50-degree field of view: 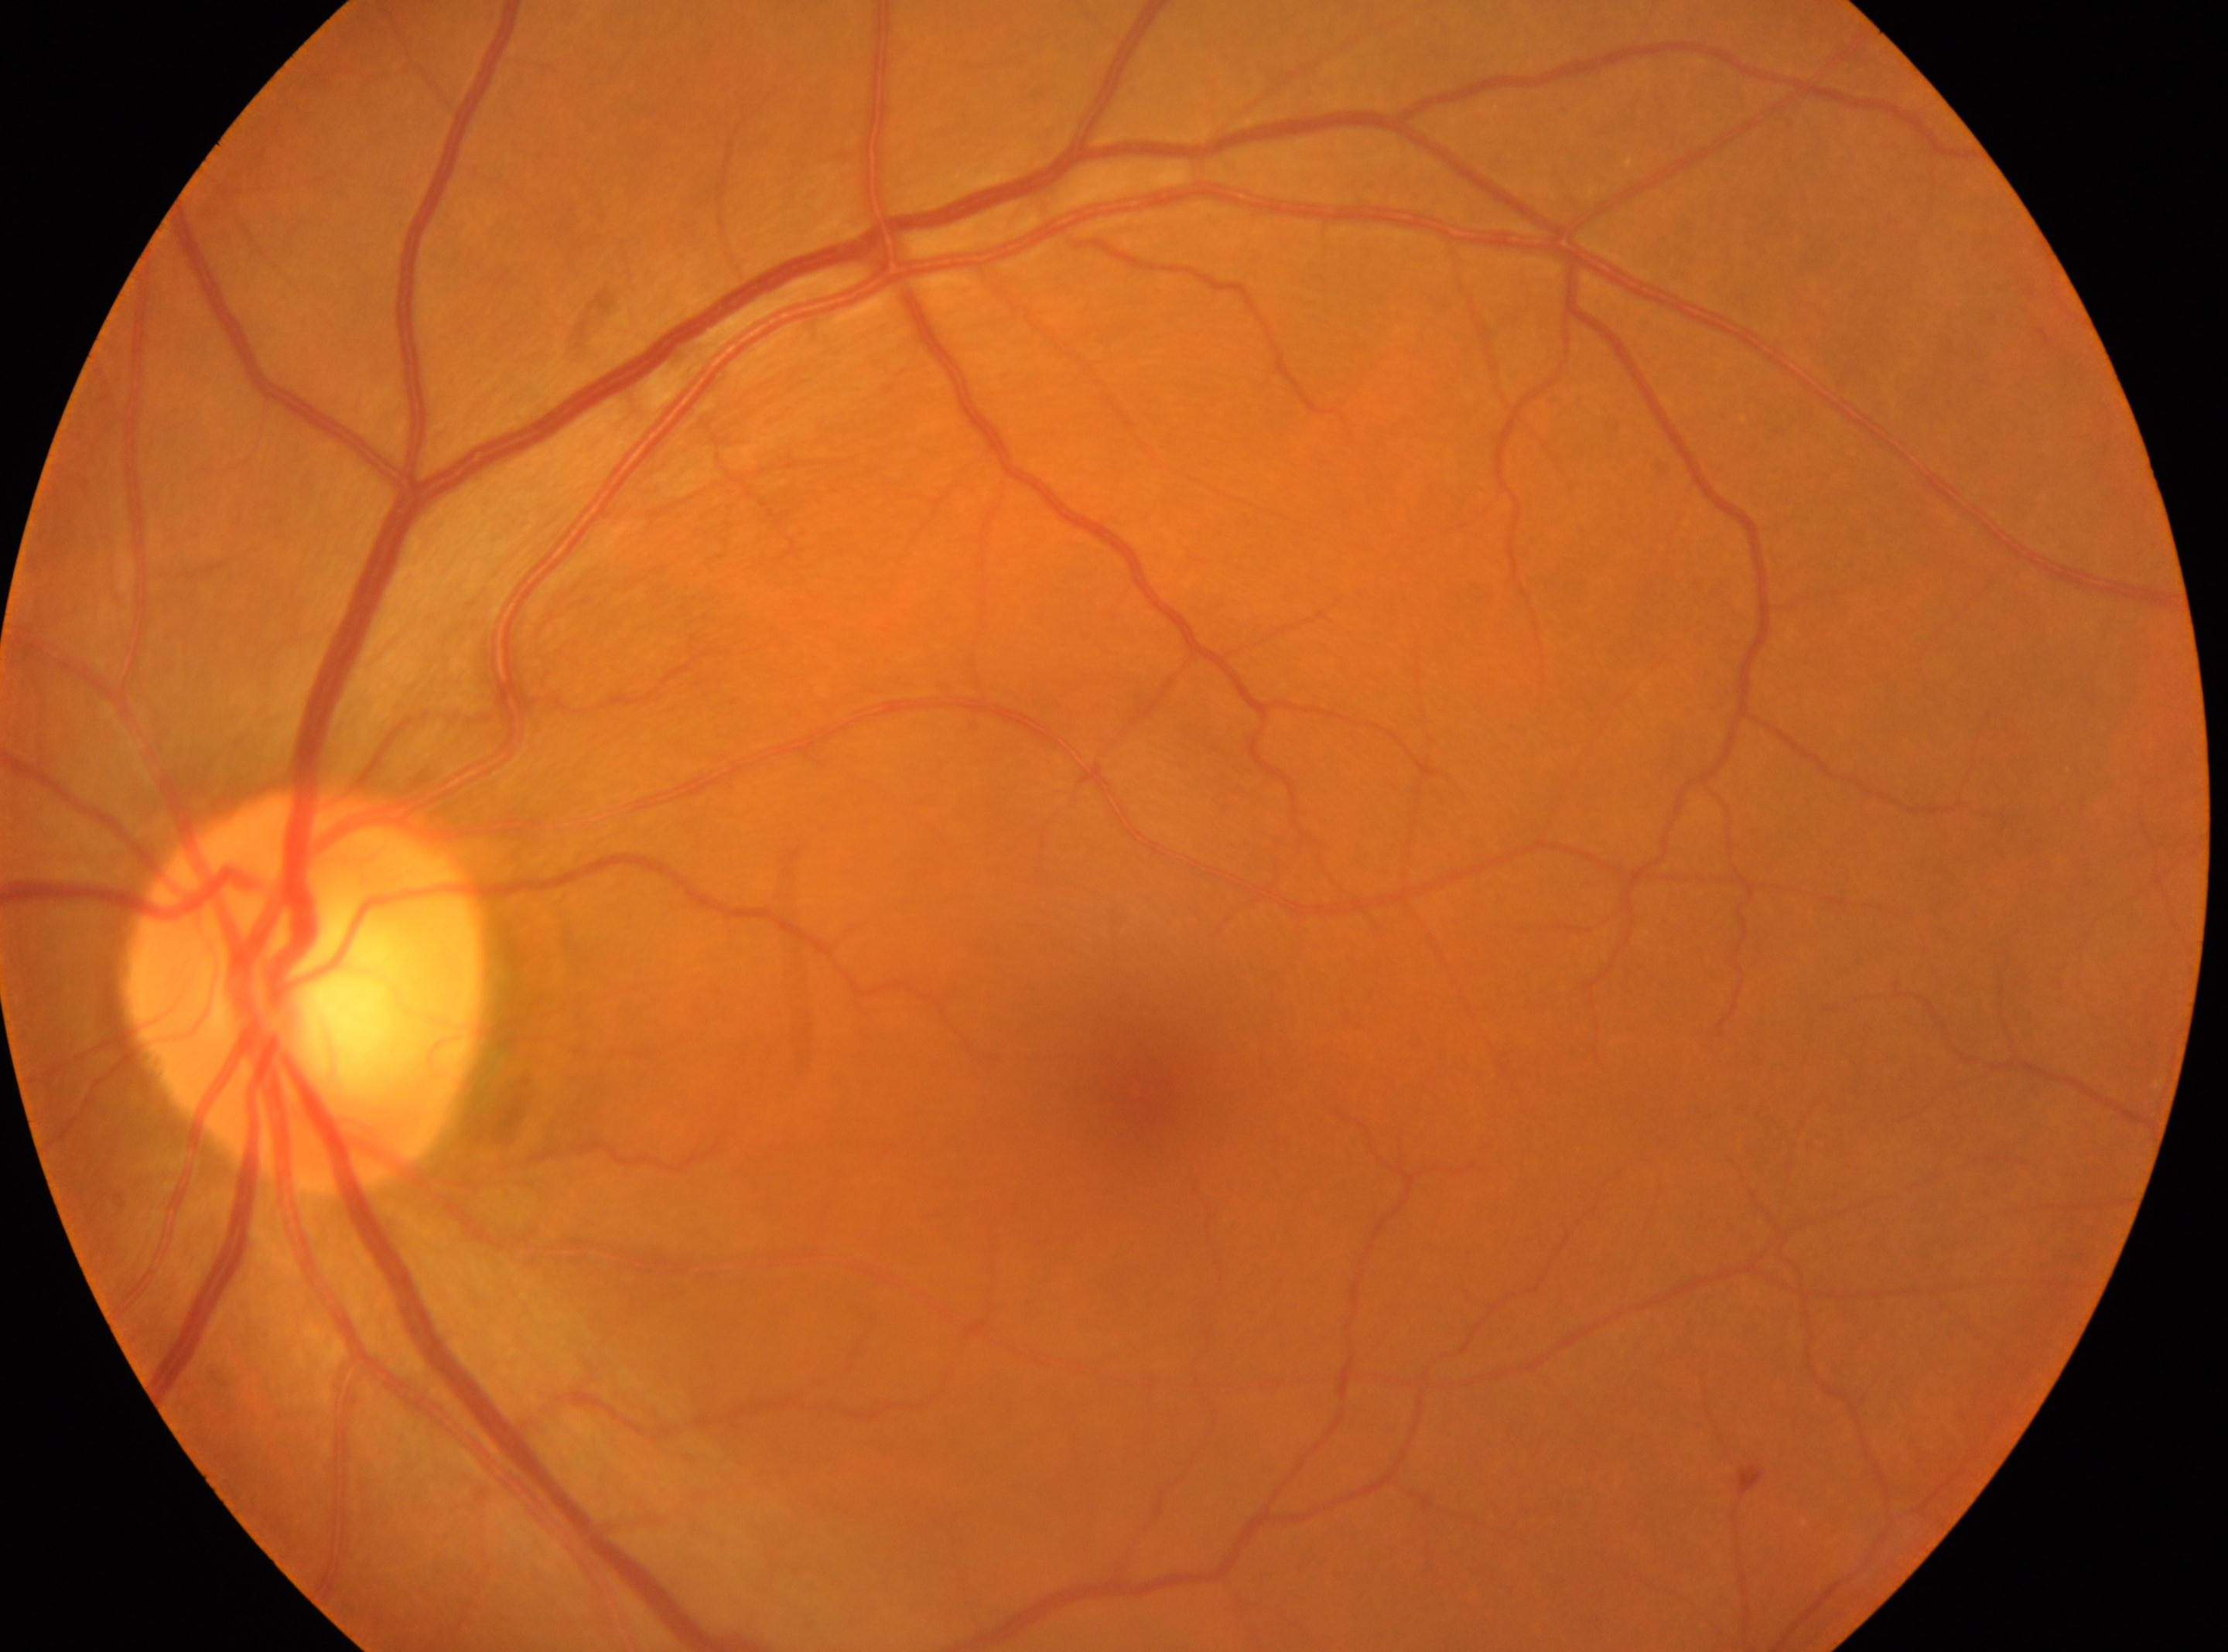 fovea: (x=1136, y=1080)
dr_grade: 0
optic_disc: (x=306, y=988)
eye: left eye